2352 by 1568 pixels. FOV: 45 degrees
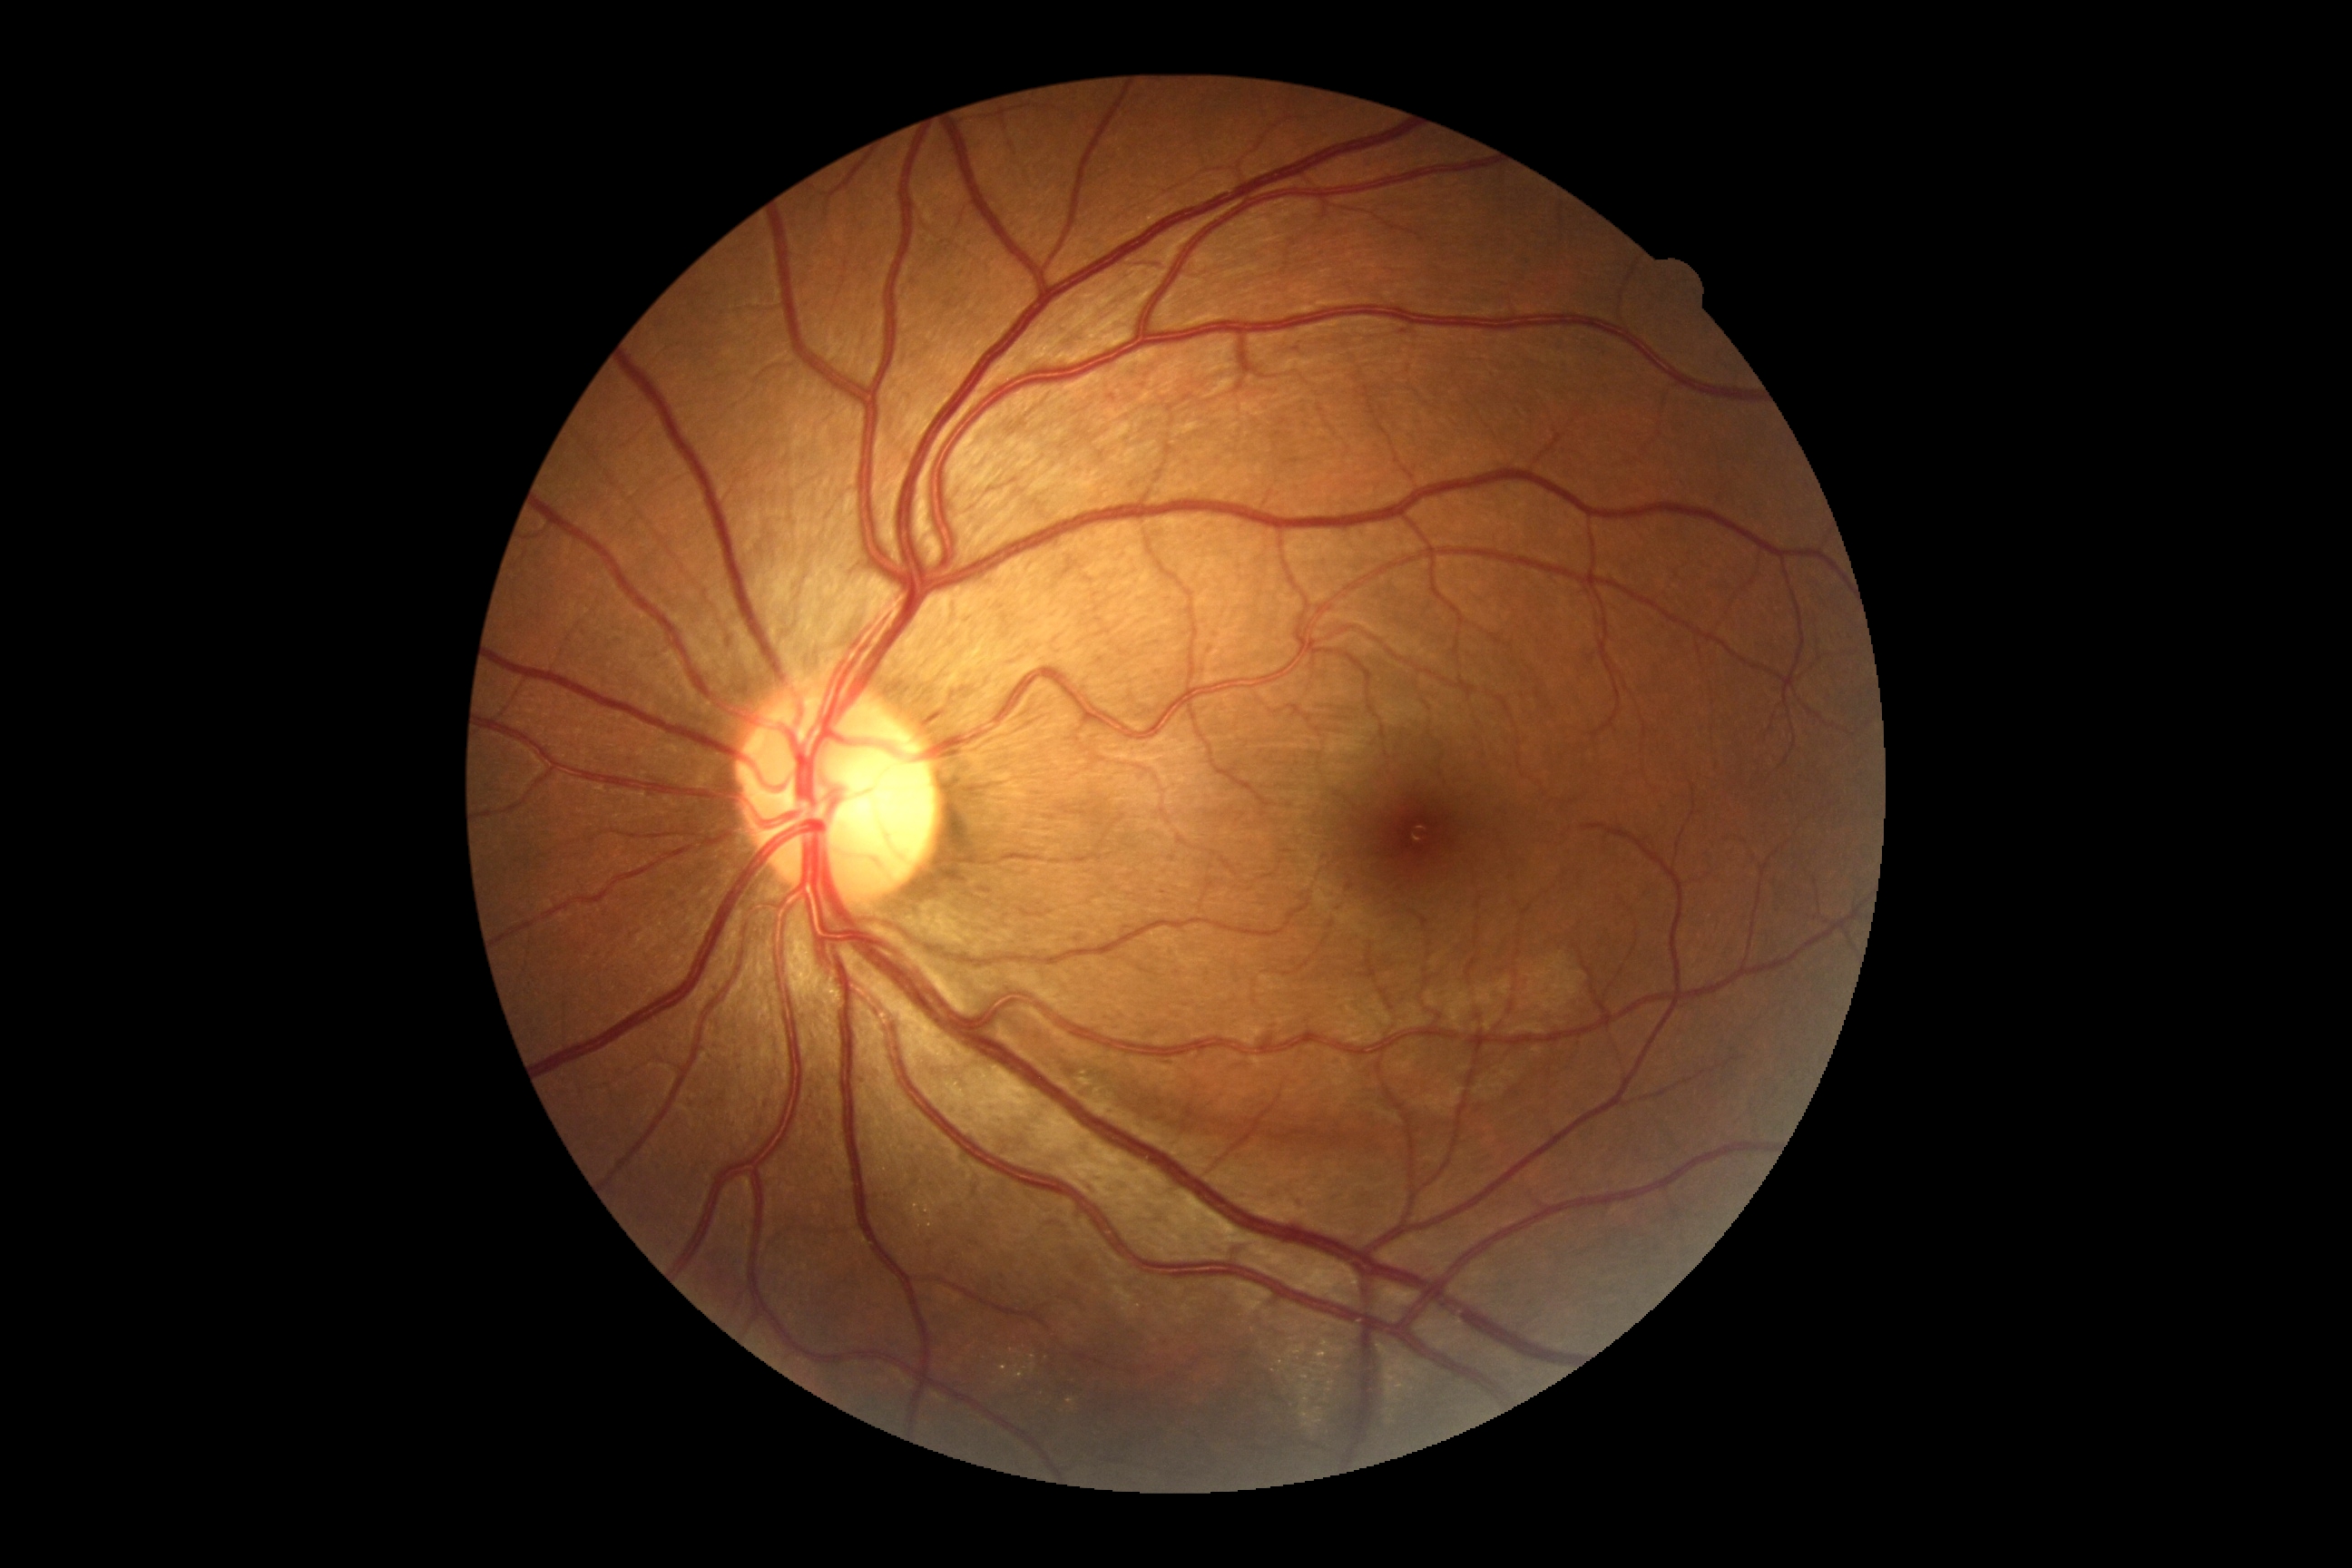

DR grade = no apparent retinopathy (0); DR impression = negative for DR.